2212x1659 — 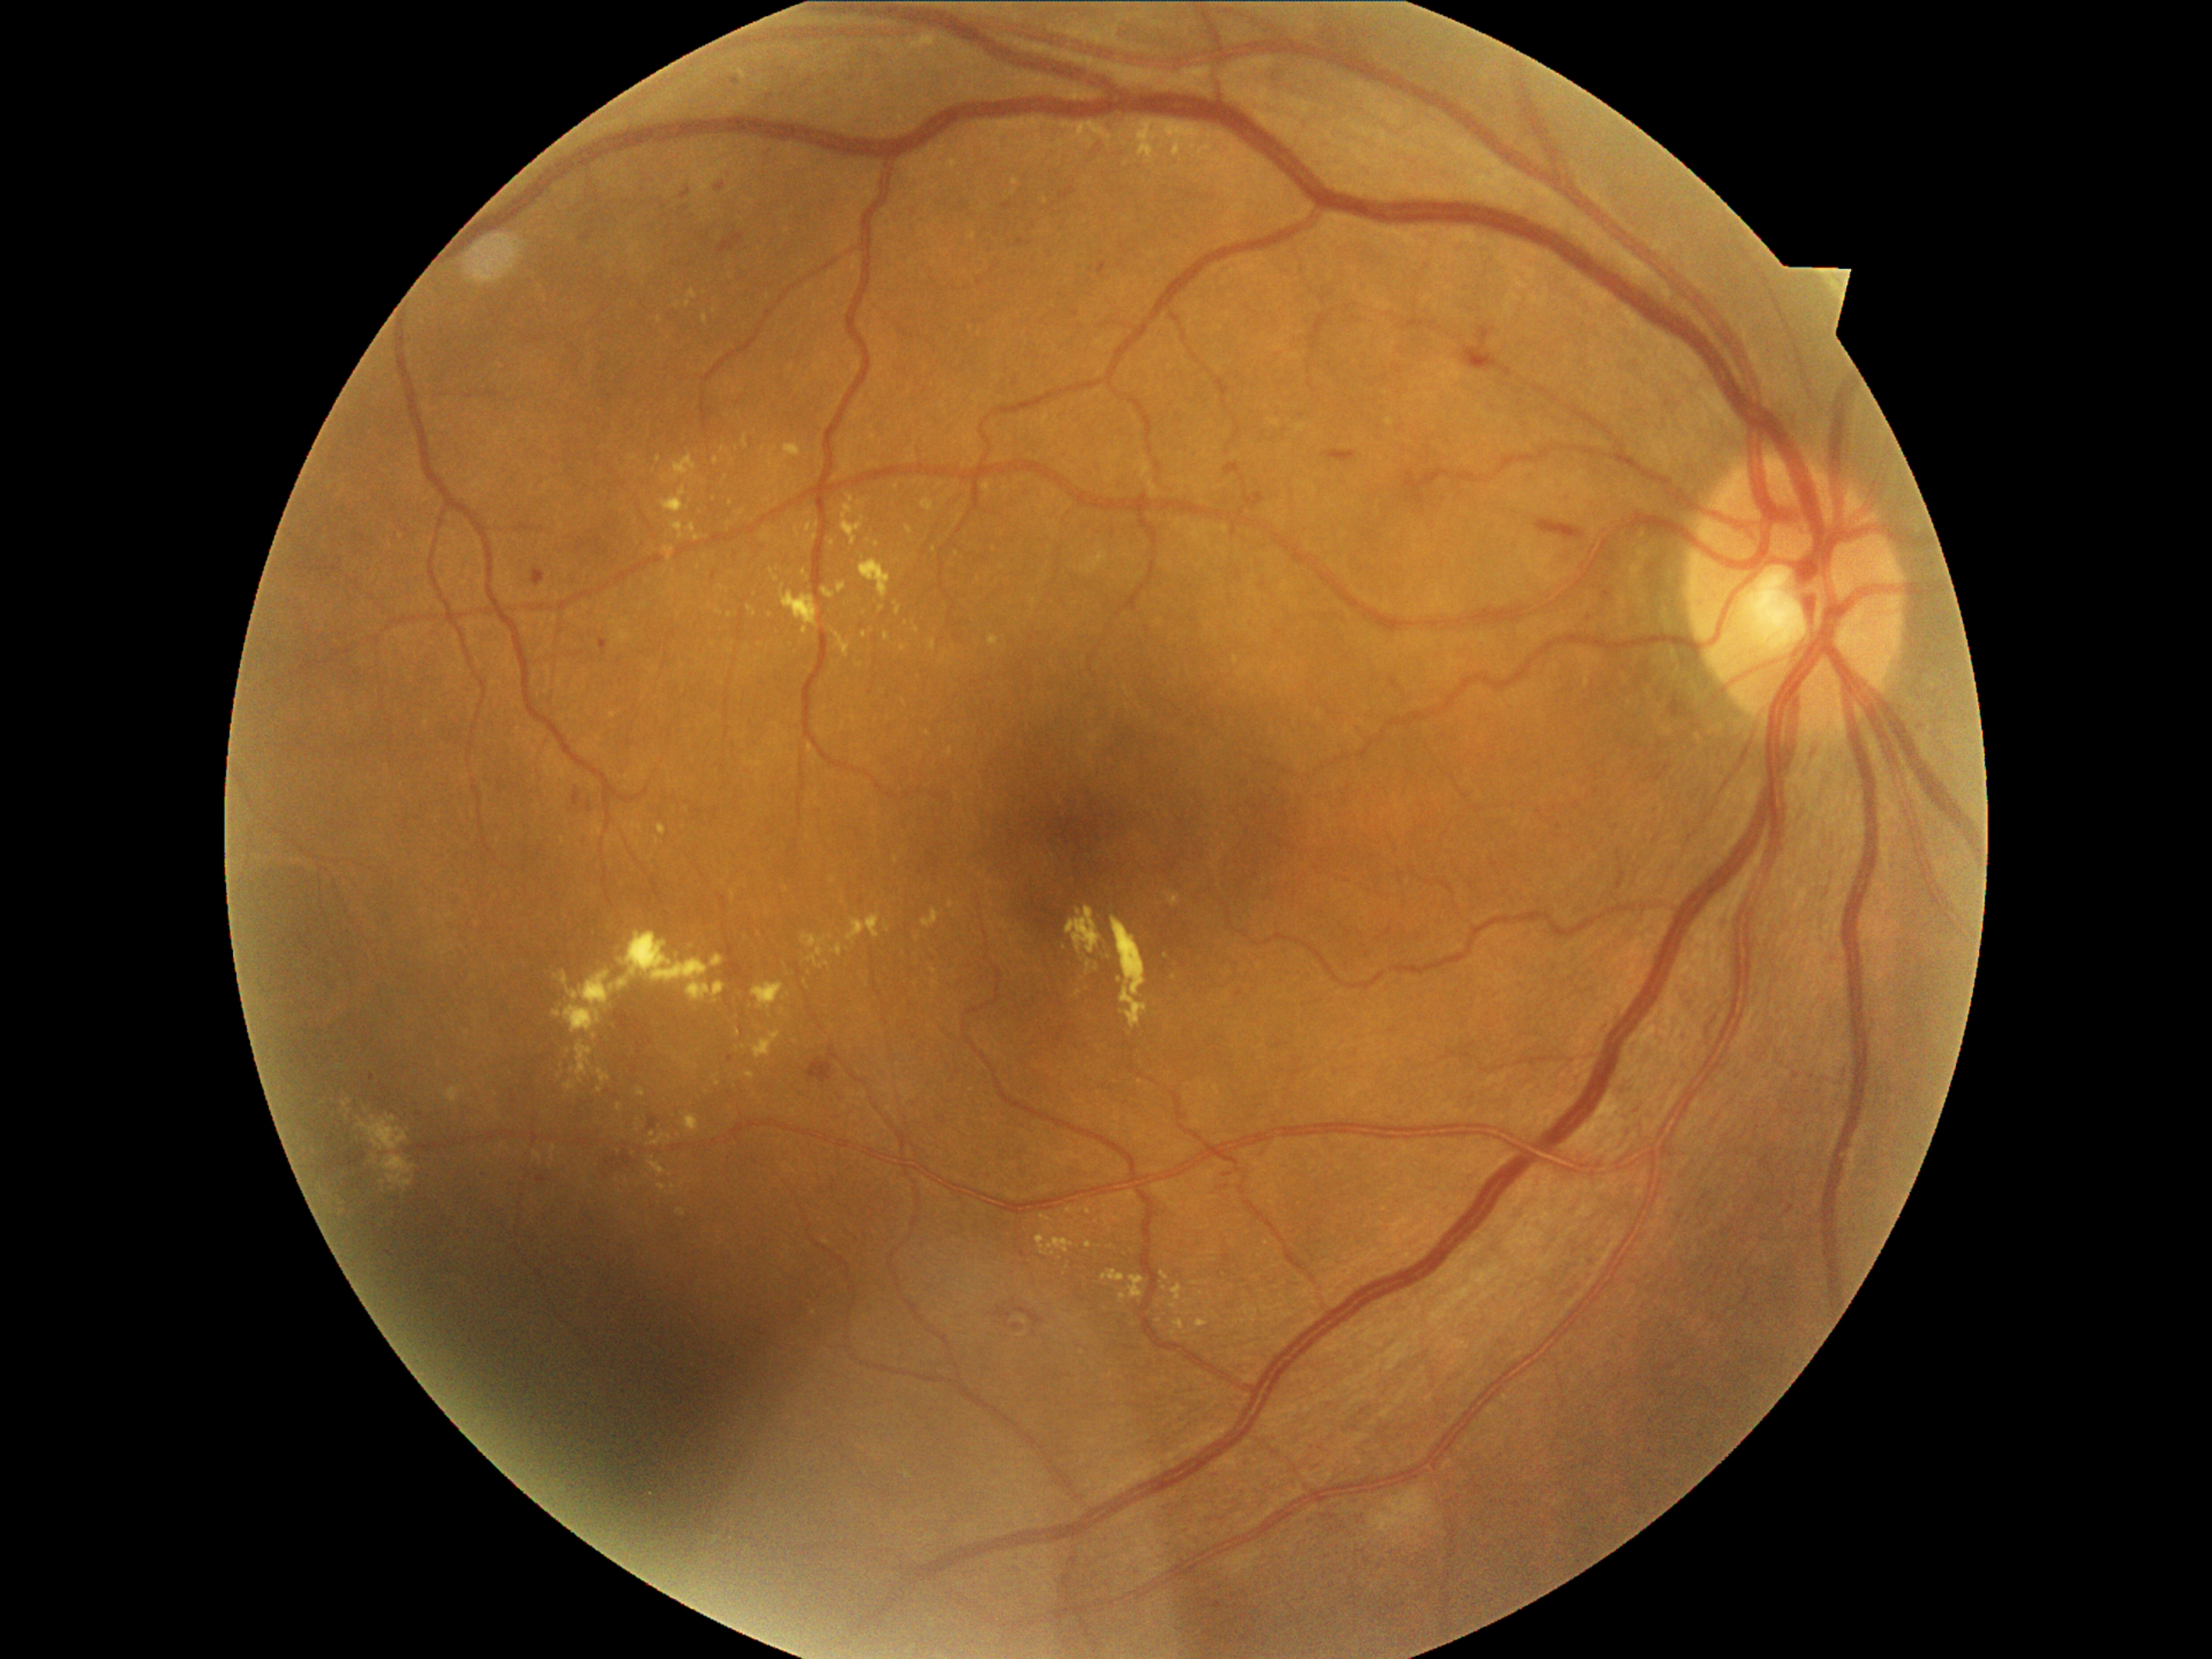

Retinopathy is moderate non-proliferative diabetic retinopathy (grade 2) — more than just microaneurysms but less than severe NPDR.
Hard exudates include lesions at 894:603:902:617 | 651:1134:673:1146 | 803:934:830:970 | 1040:1214:1051:1221 | 1066:907:1102:955 | 832:631:851:658 | 905:527:912:535 | 677:1208:685:1216 | 713:1074:721:1086 | 1168:892:1180:905.
Hard exudates (small, approximate centers) near (554; 1149) | (677; 308) | (903; 649) | (653; 1135) | (882; 609) | (887; 929) | (559; 1078) | (782; 1011).